Wide-field contact fundus photograph of an infant.
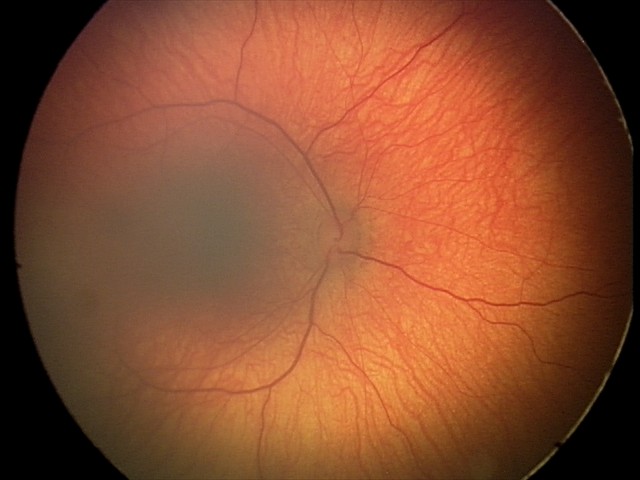

Examination with physiological retinal findings.